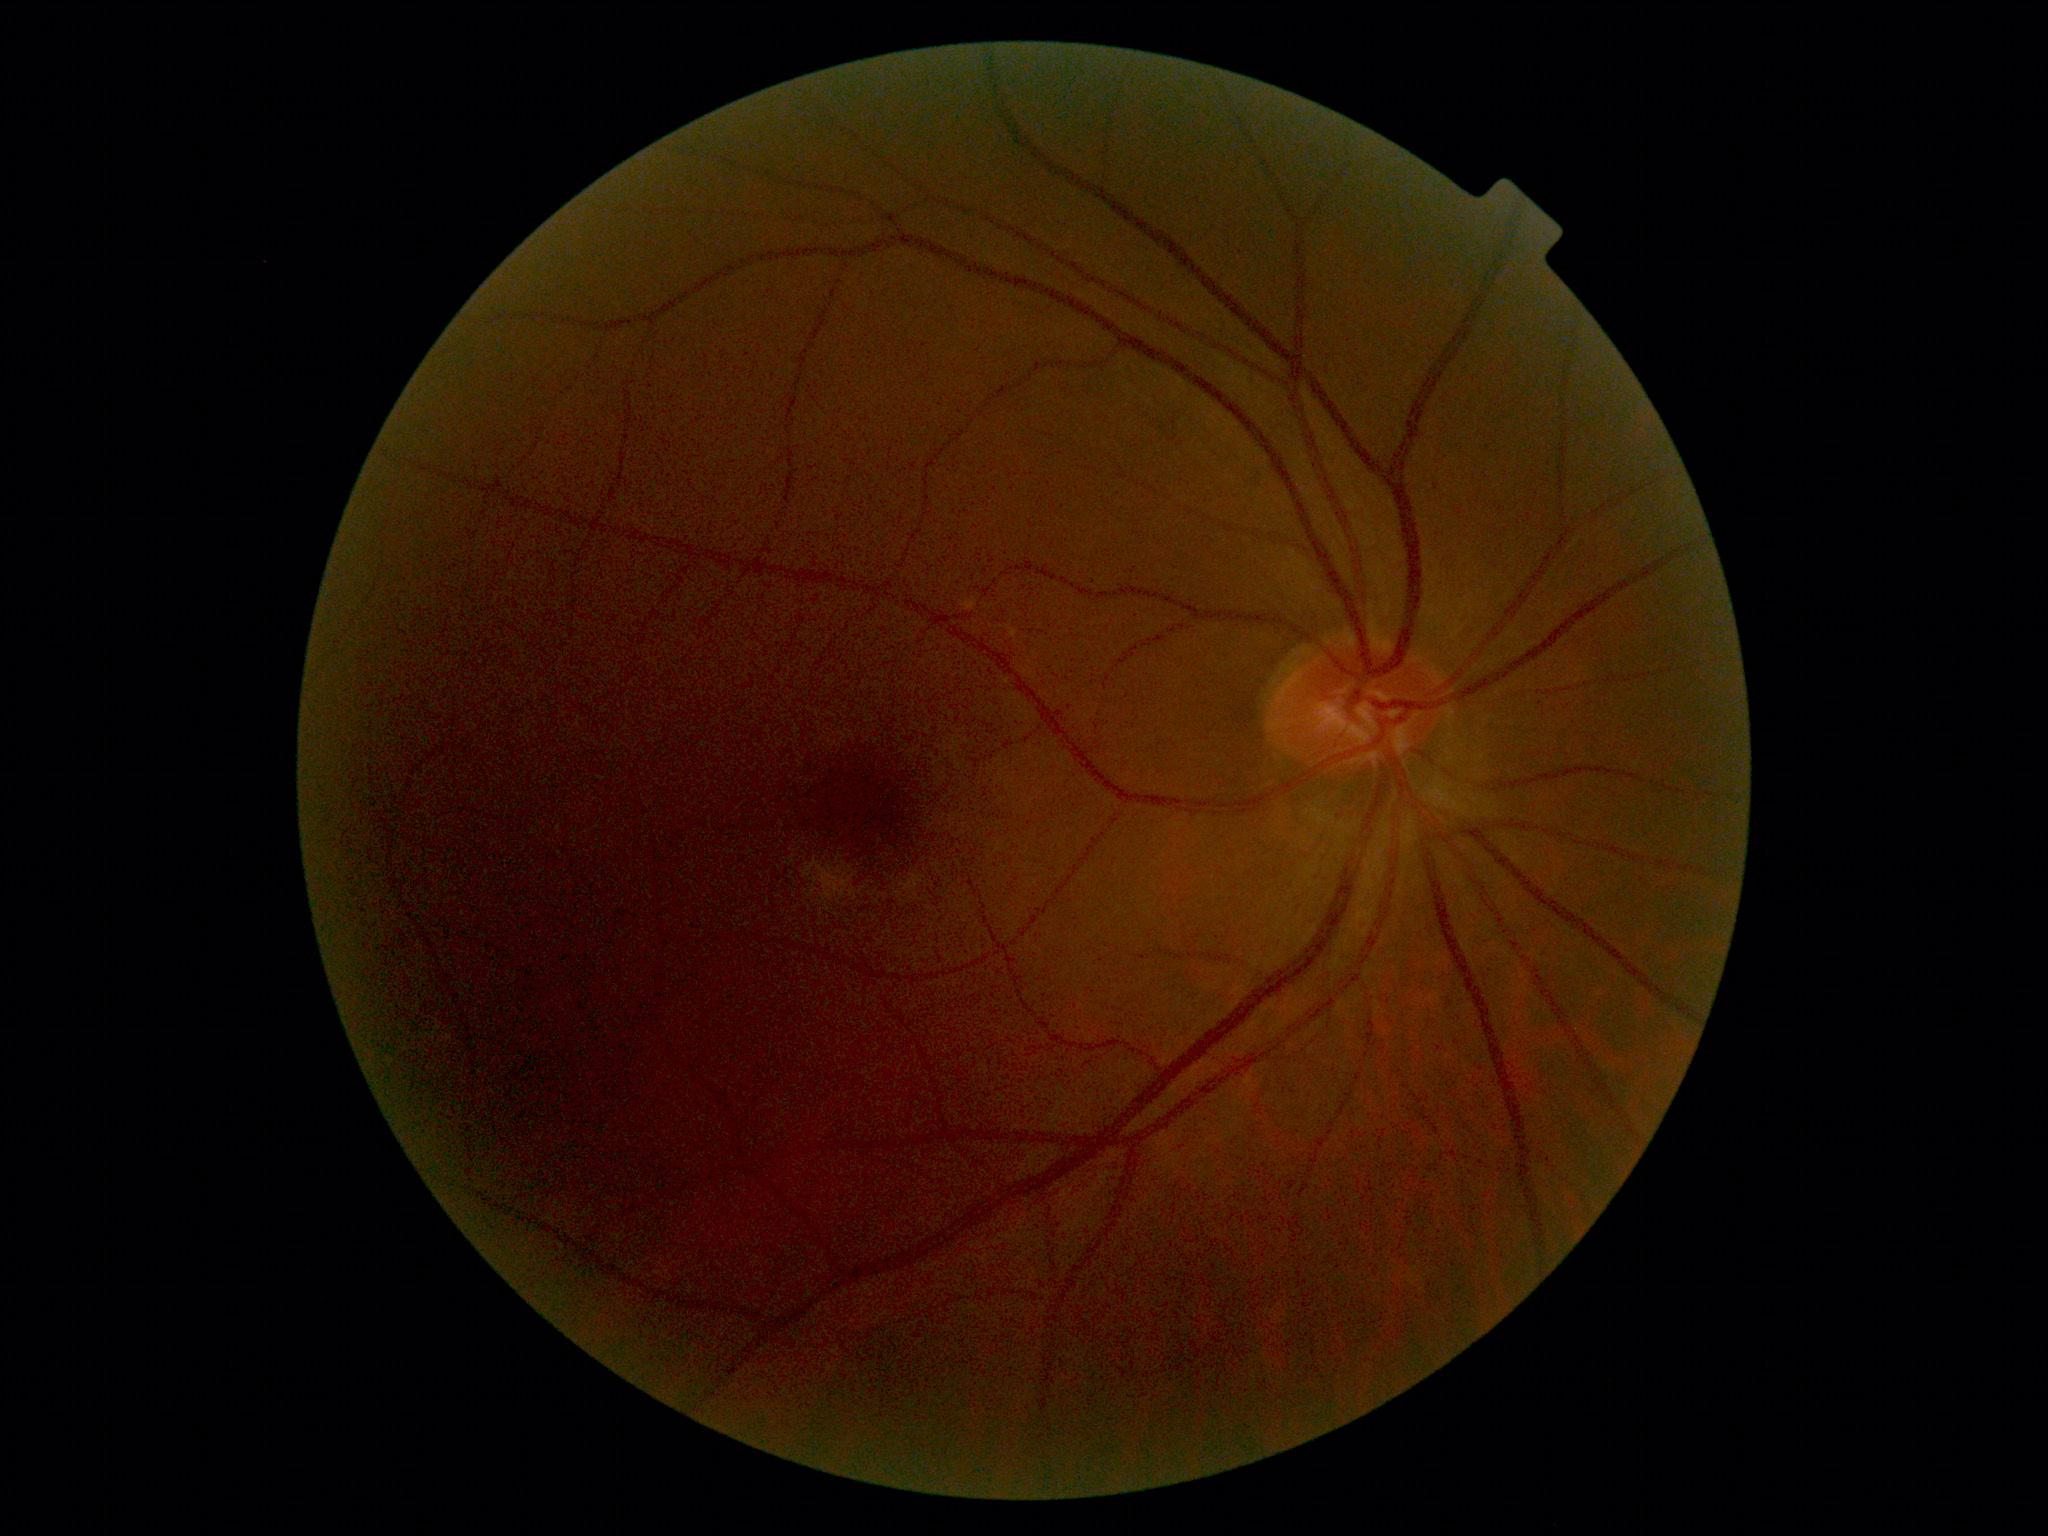

DR impression@no signs of DR; diabetic retinopathy severity@0 — no visible signs of diabetic retinopathy.